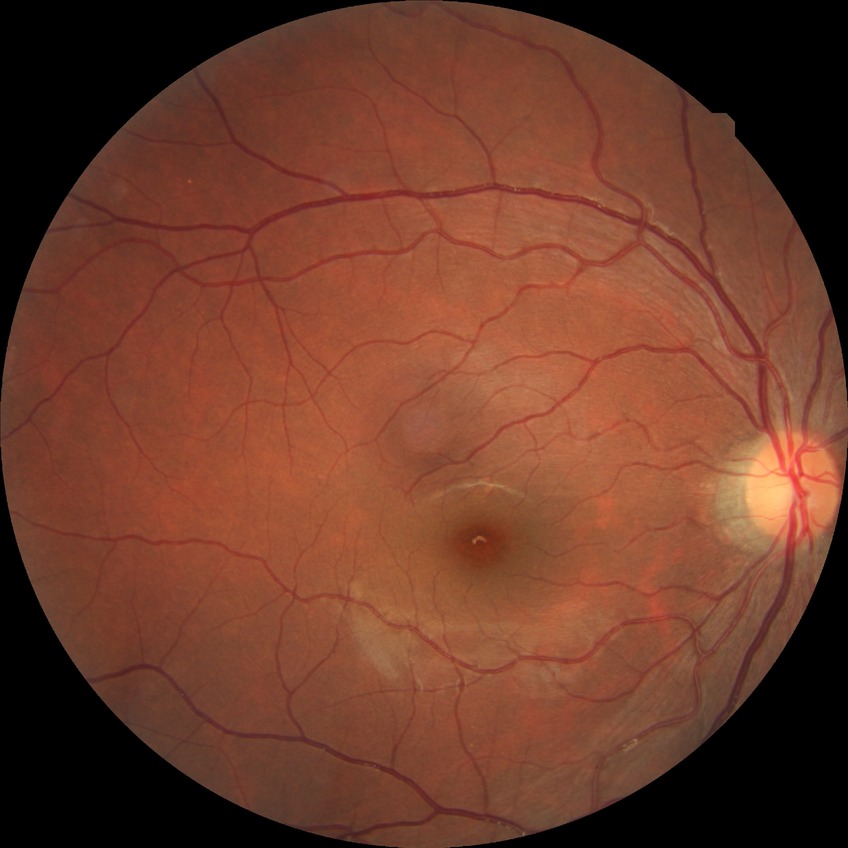
modified Davis classification = no diabetic retinopathy.